Davis DR grading:
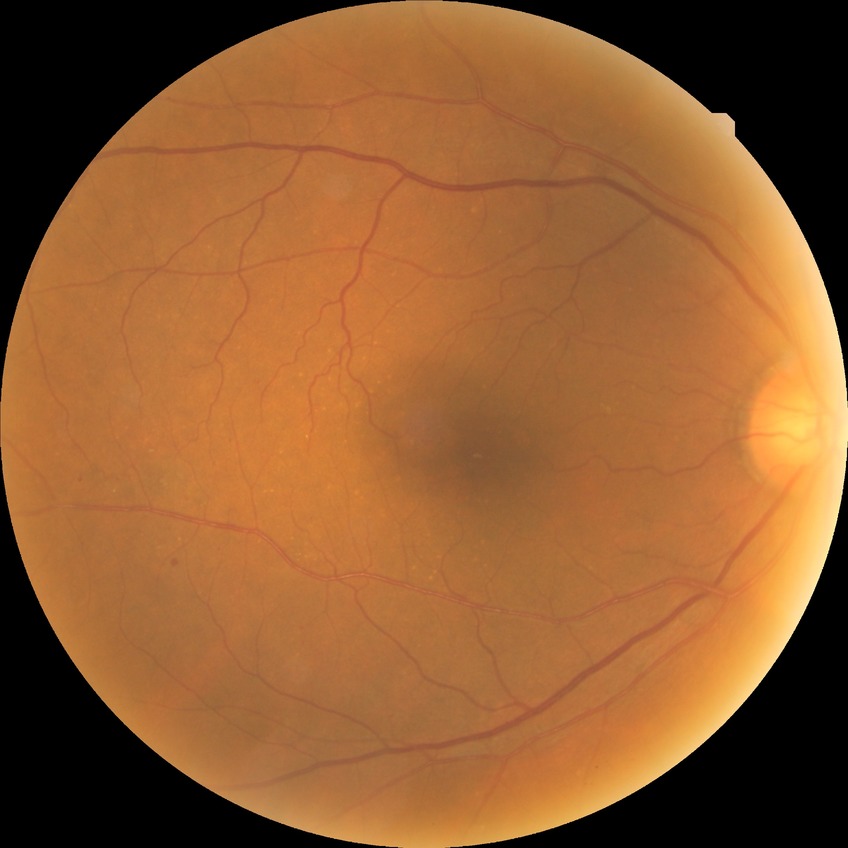 diabetic retinopathy (DR)@SDR (simple diabetic retinopathy).